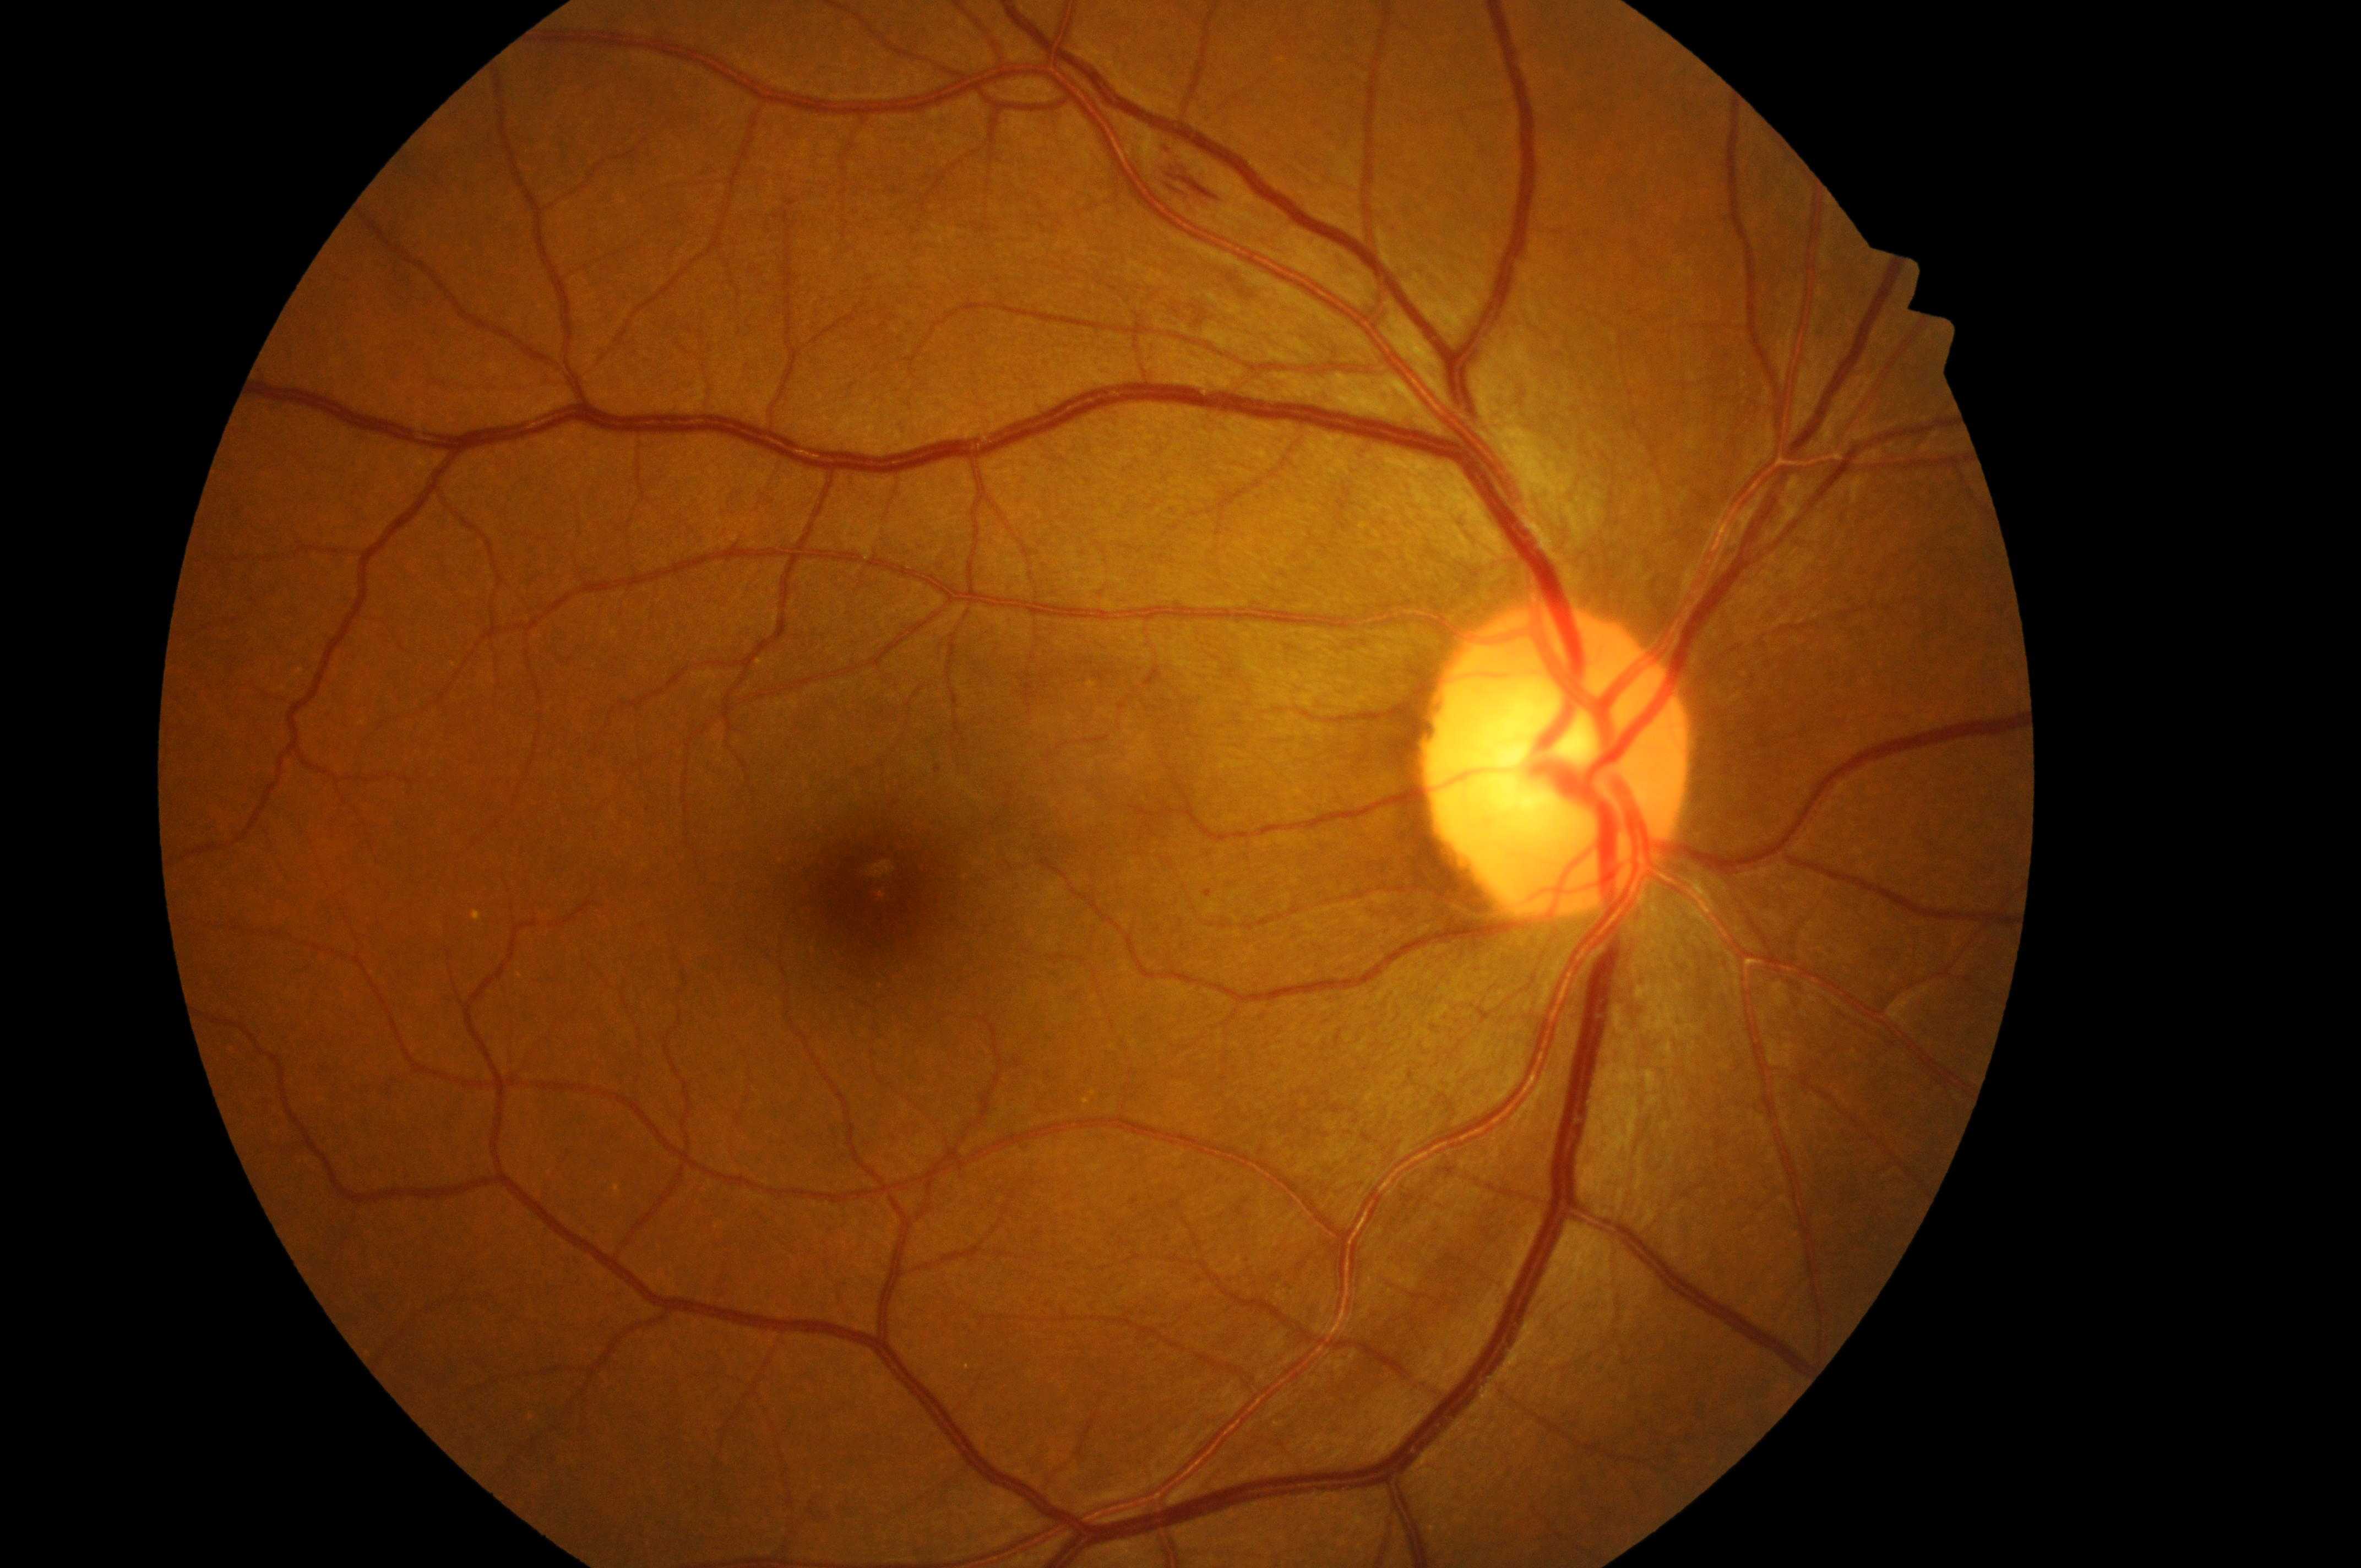 {
  "dr_grade": "moderate non-proliferative diabetic retinopathy (grade 2)",
  "optic_disc": "(1557,777)",
  "dme_grade": "low risk (grade 1)",
  "dr_category": "non-proliferative diabetic retinopathy",
  "eye": "right eye",
  "fovea": "(877,897)"
}